Axial length 22.94 mm
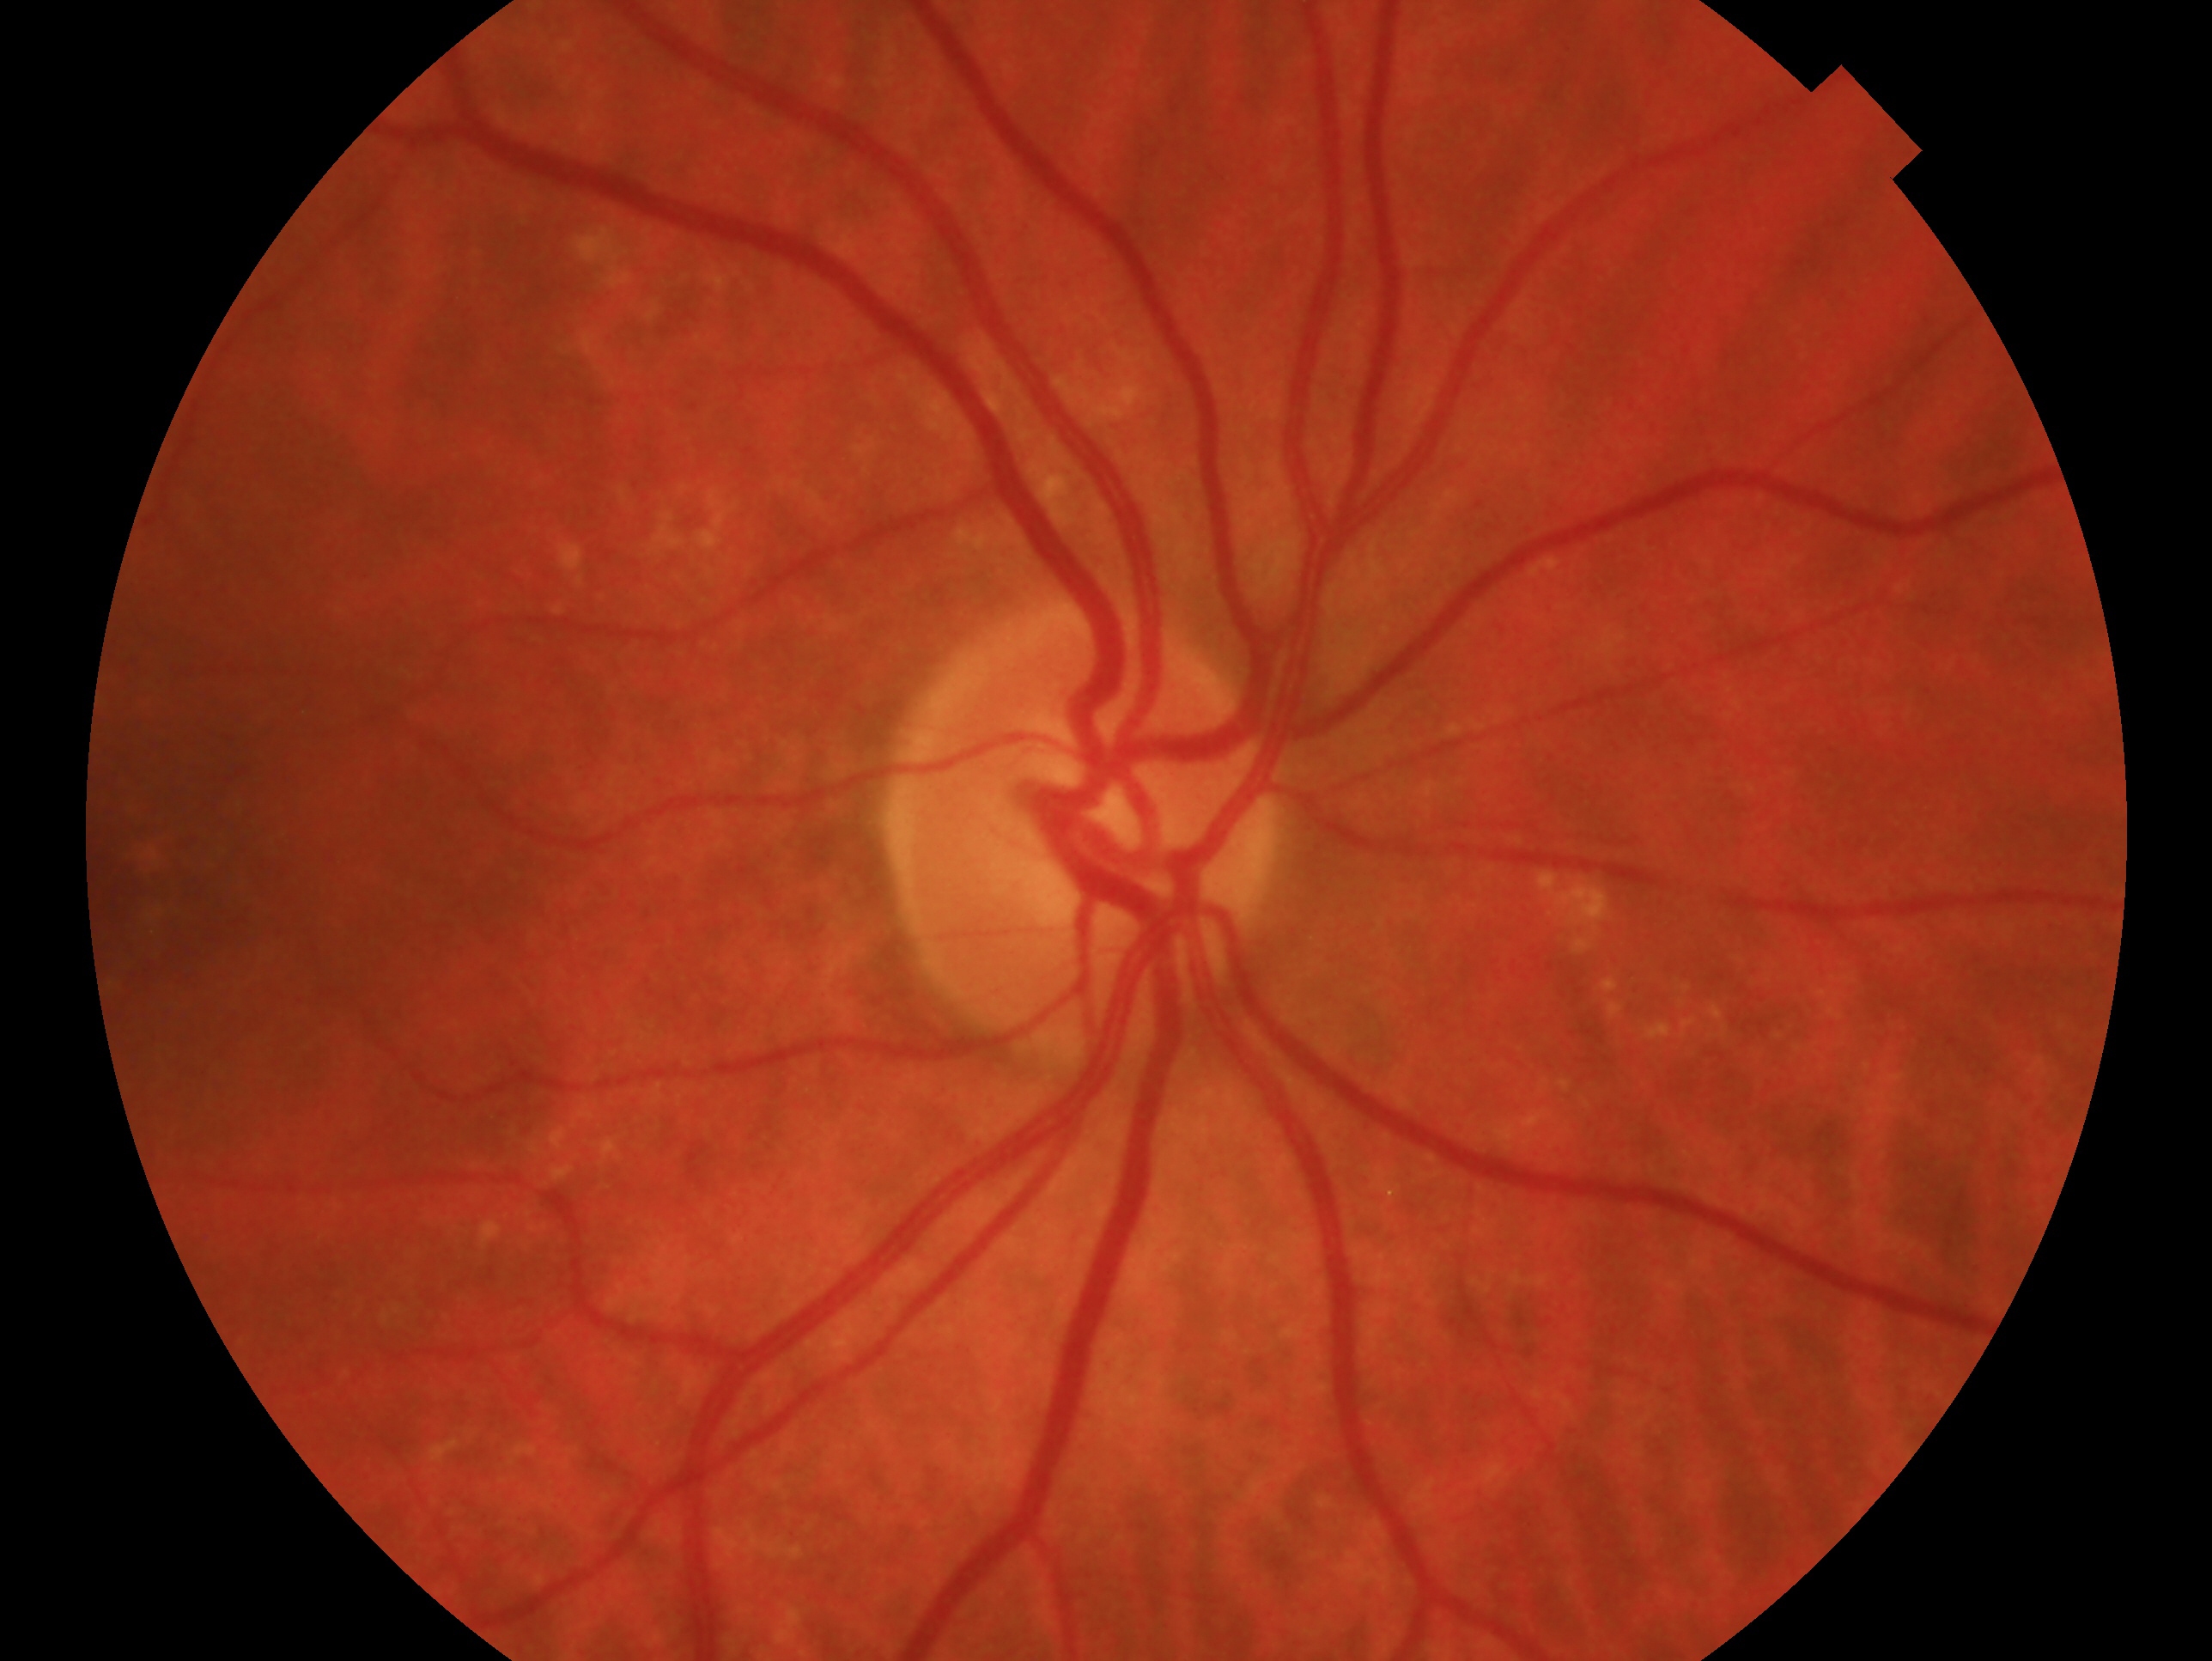
Eye: OD.
Glaucoma status — negative for glaucoma.